No pharmacologic dilation · image size 848x848 · 45 degree fundus photograph · NIDEK AFC-230
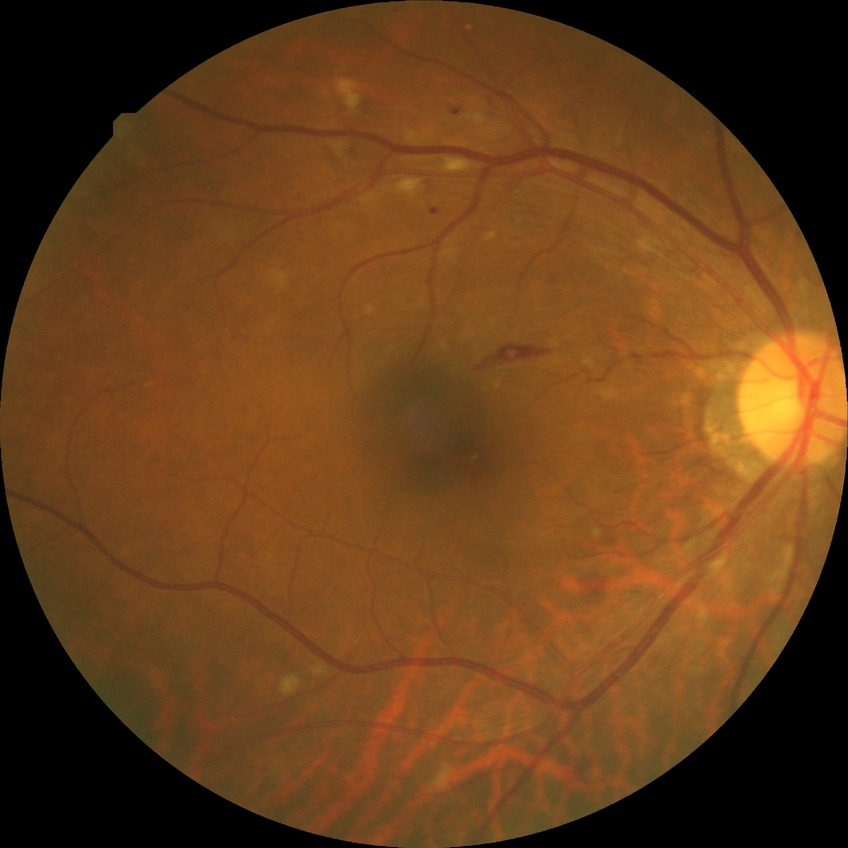 retinopathy grade@pre-proliferative diabetic retinopathy.